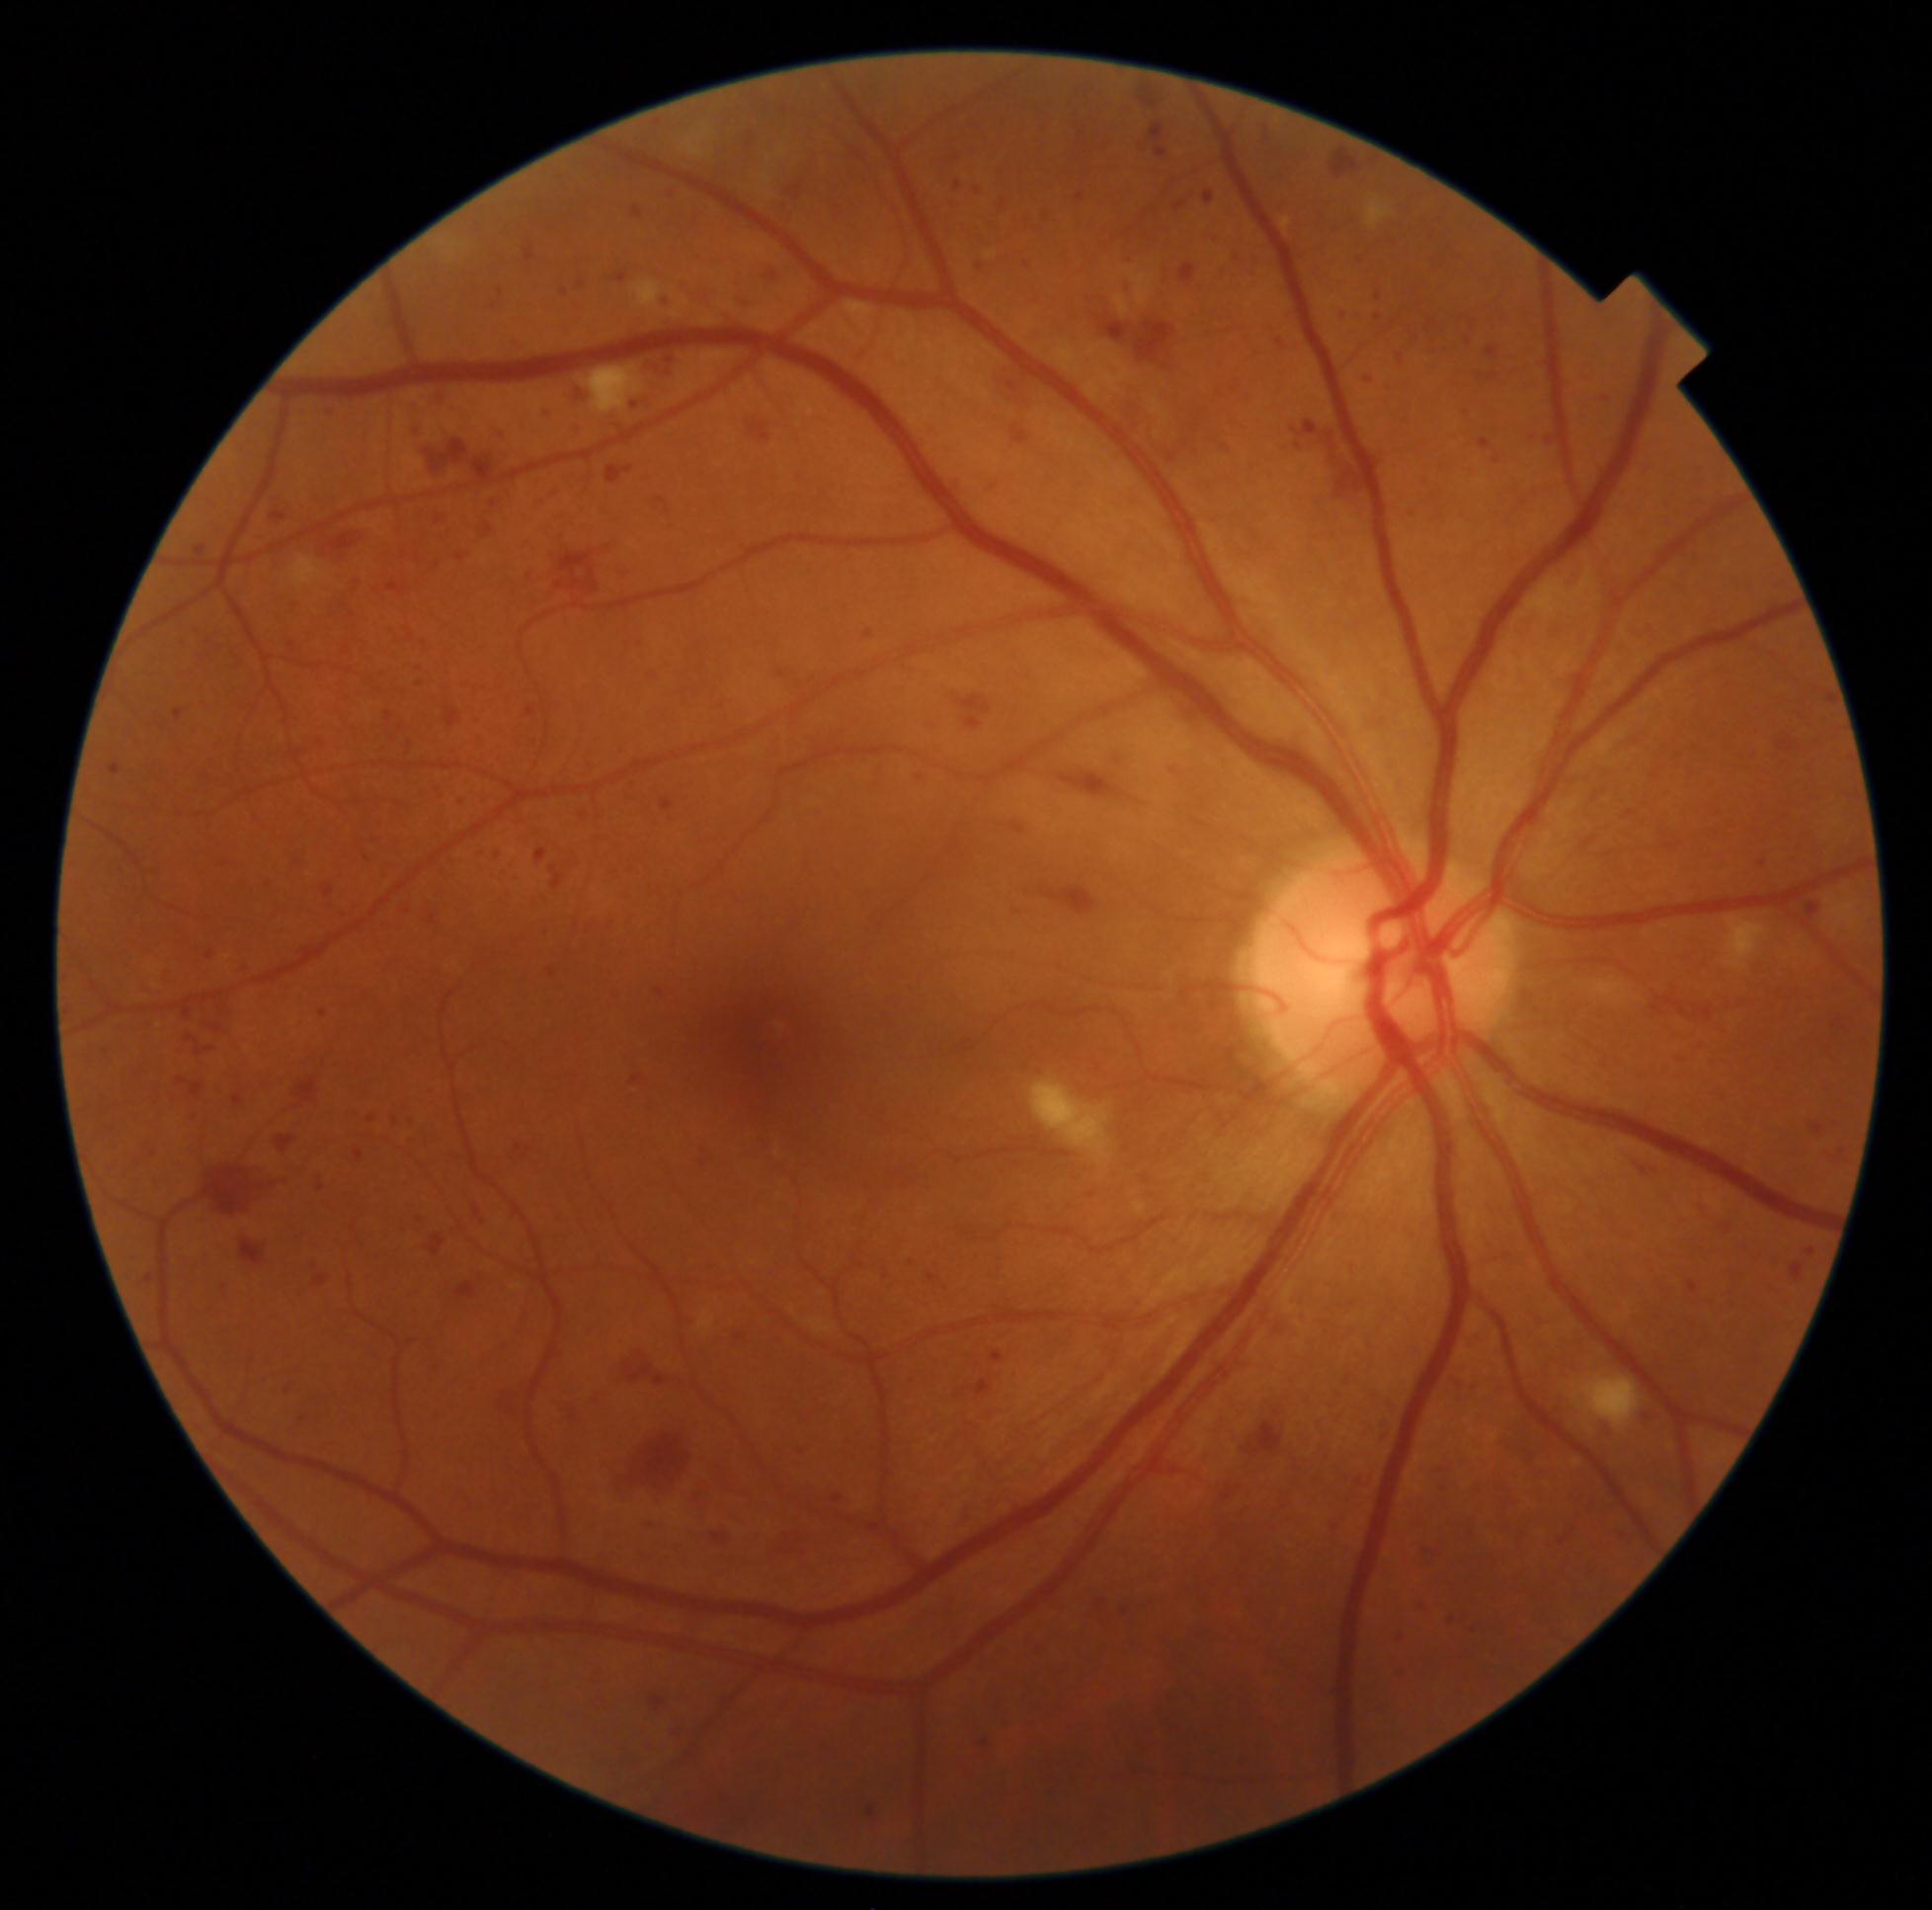
Retinopathy grade: 3.
Hemorrhages (partial list) at {"x1": 570, "y1": 923, "x2": 583, "y2": 936}; {"x1": 586, "y1": 1386, "x2": 609, "y2": 1409}; {"x1": 666, "y1": 815, "x2": 675, "y2": 824}; {"x1": 1203, "y1": 193, "x2": 1214, "y2": 204}; {"x1": 1406, "y1": 505, "x2": 1419, "y2": 520}; {"x1": 1691, "y1": 1200, "x2": 1713, "y2": 1217}; {"x1": 1541, "y1": 434, "x2": 1559, "y2": 449}; {"x1": 177, "y1": 638, "x2": 193, "y2": 647}; {"x1": 1428, "y1": 344, "x2": 1450, "y2": 358}; {"x1": 1150, "y1": 124, "x2": 1167, "y2": 142}; {"x1": 754, "y1": 264, "x2": 786, "y2": 288}; {"x1": 937, "y1": 686, "x2": 999, "y2": 733}; {"x1": 610, "y1": 562, "x2": 630, "y2": 583}; {"x1": 641, "y1": 351, "x2": 681, "y2": 381}; {"x1": 1121, "y1": 1609, "x2": 1129, "y2": 1616}; {"x1": 163, "y1": 1089, "x2": 179, "y2": 1104}; {"x1": 1220, "y1": 442, "x2": 1236, "y2": 454}; {"x1": 601, "y1": 412, "x2": 625, "y2": 432}.
Smaller hemorrhages around (1379, 297); (348, 647).